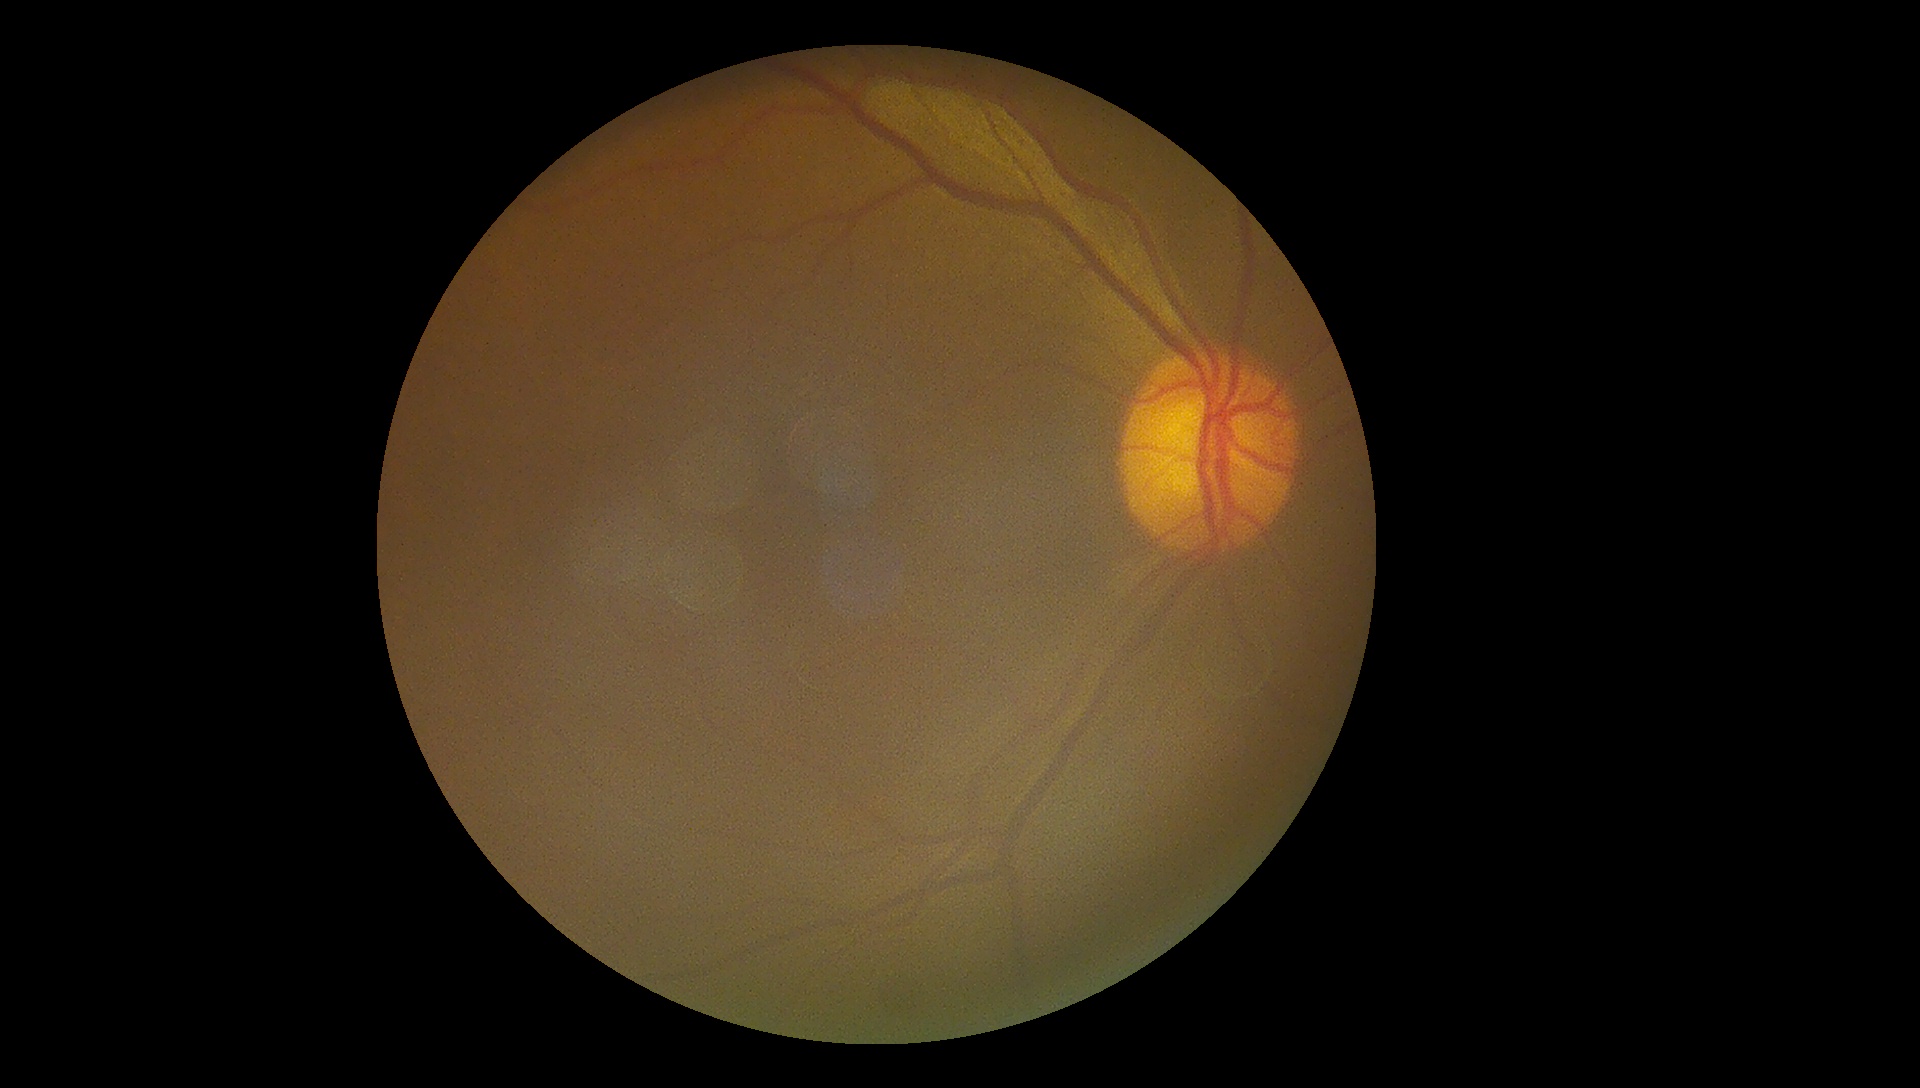 Quality too poor to assess for DR. Diabetic retinopathy (DR): ungradable.